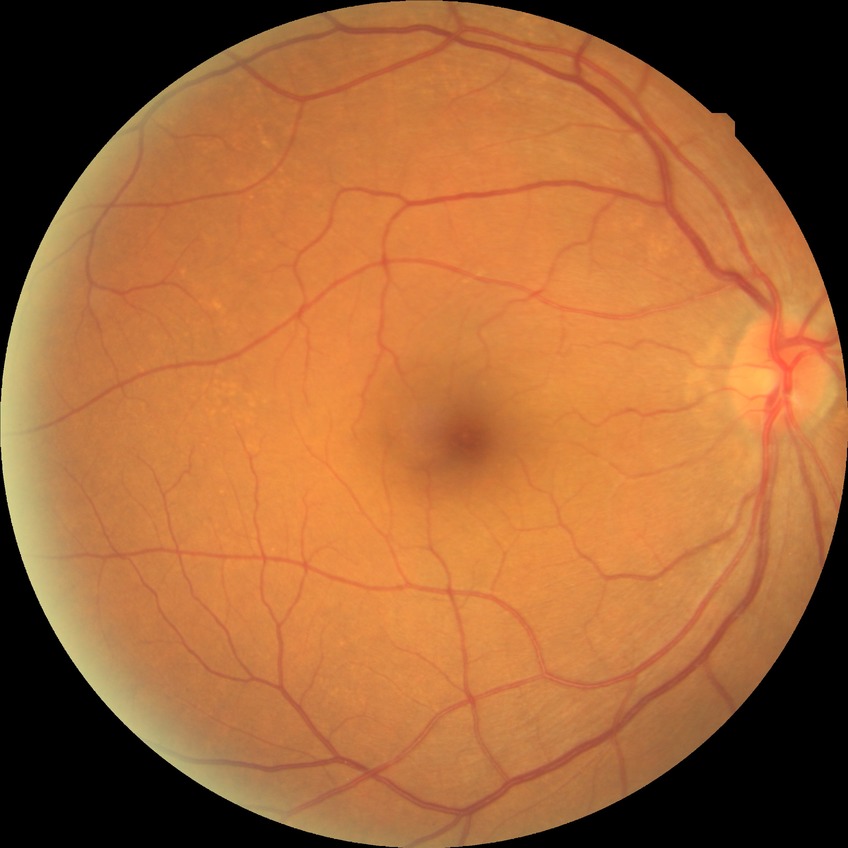

Findings:
• diabetic retinopathy (DR): no diabetic retinopathy (NDR)